45° field of view · 848x848px · acquired with a NIDEK AFC-230 · nonmydriatic: 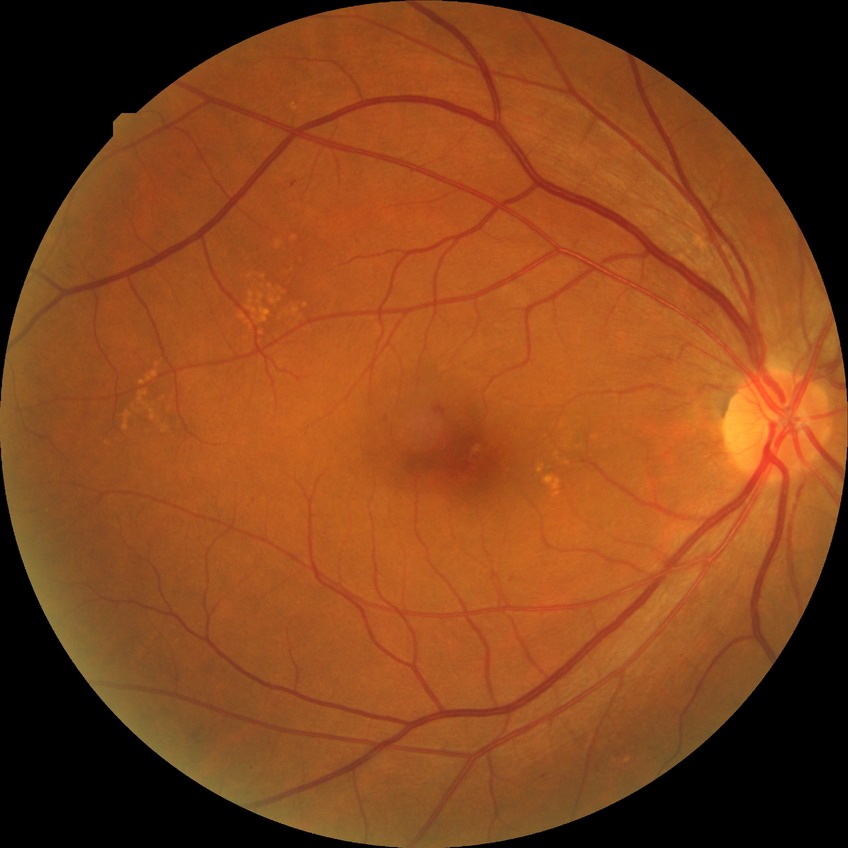

Retinopathy stage is simple diabetic retinopathy.